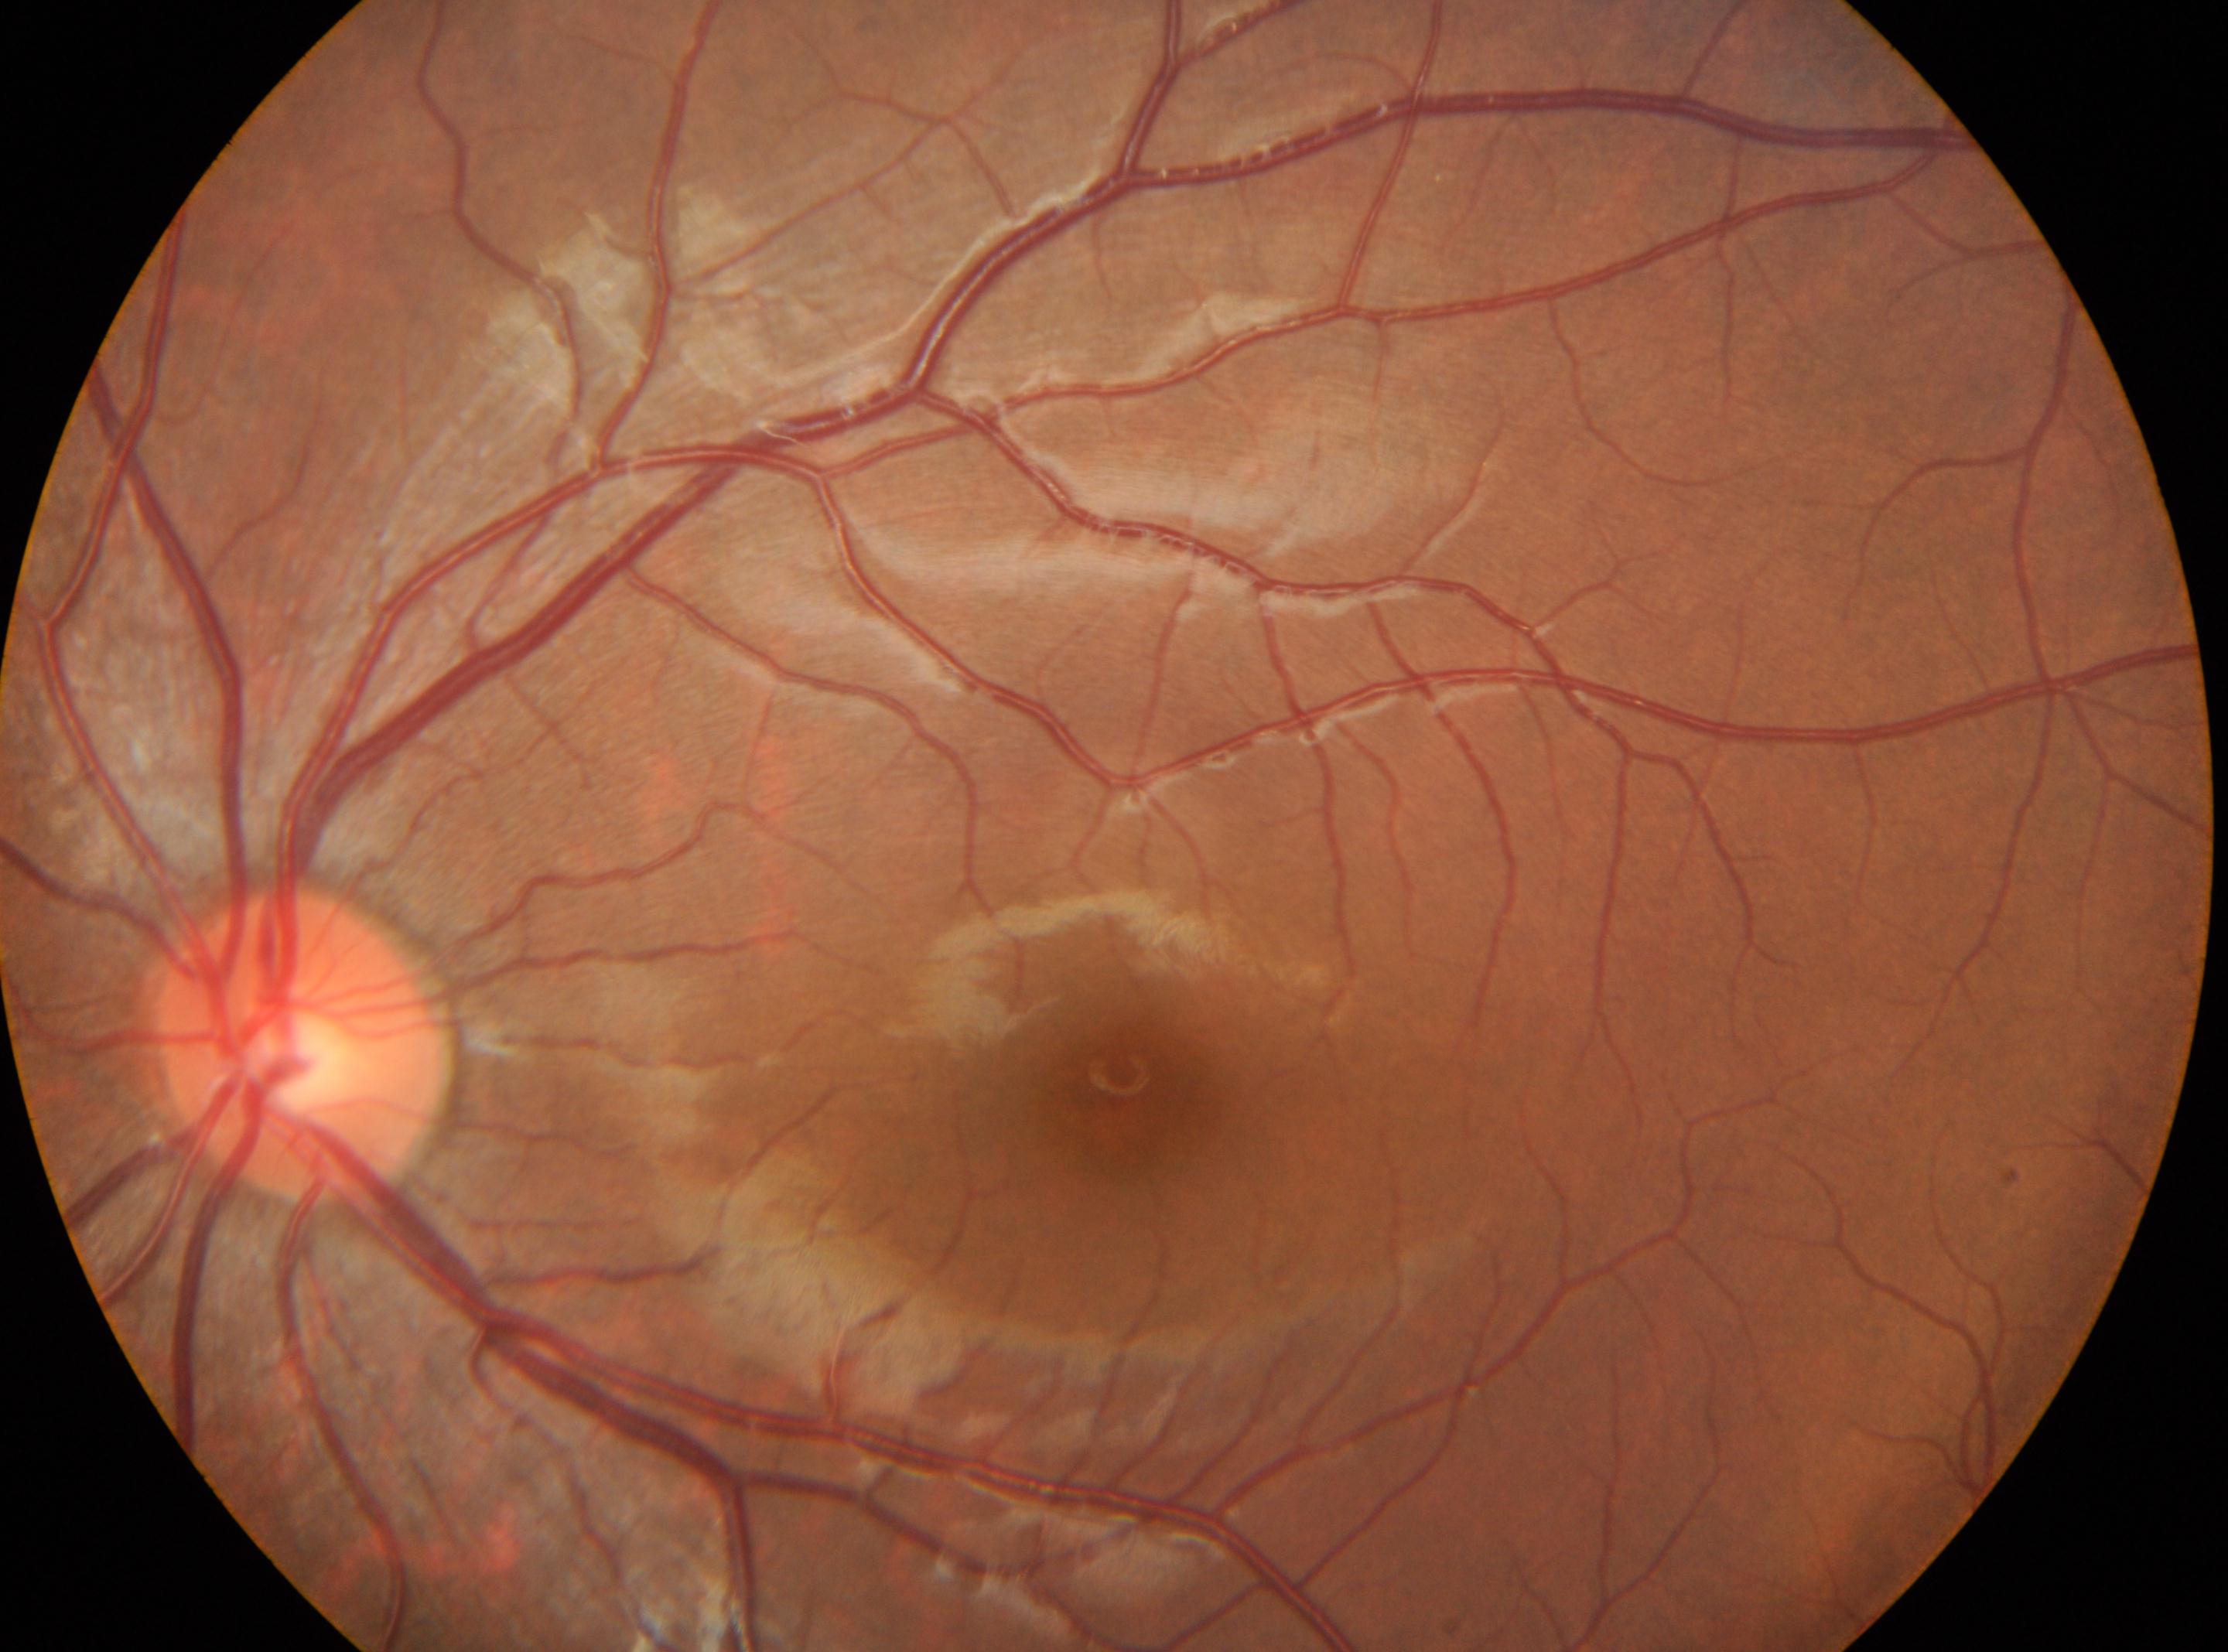 The optic disk is at (x: 299, y: 1043).
Eye: OS.
Diabetic retinopathy (DR) is grade 0 (no apparent retinopathy).
Macula center located at (x: 1126, y: 1103).